DR severity per modified Davis staging. Camera: NIDEK AFC-230
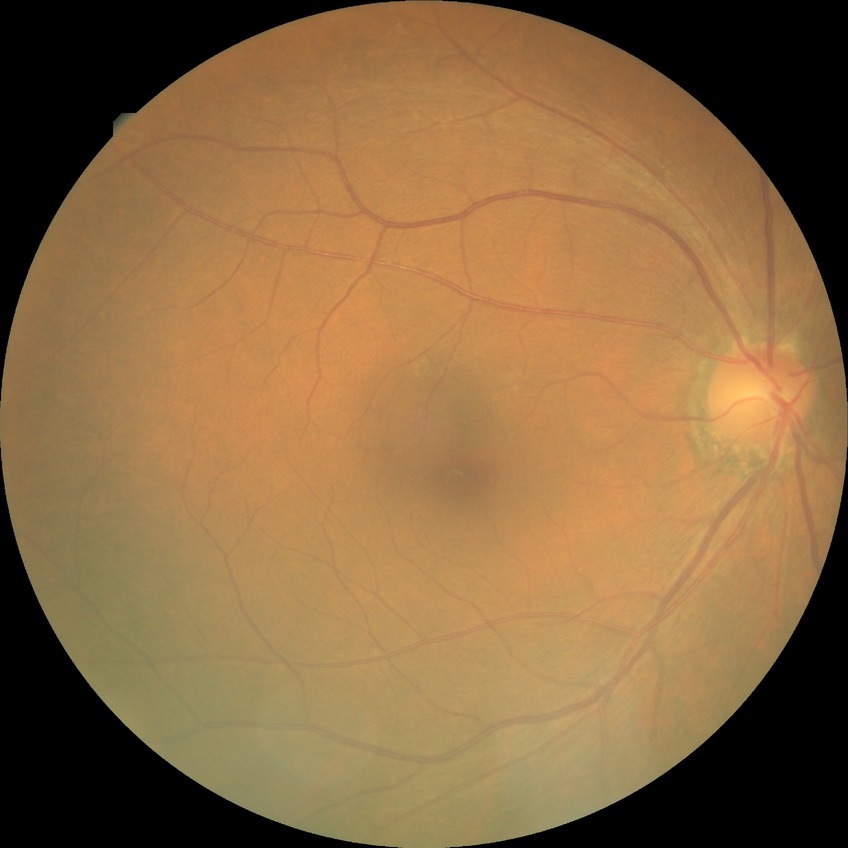

diabetic retinopathy (DR)@no diabetic retinopathy (NDR).